Infant wide-field retinal image: 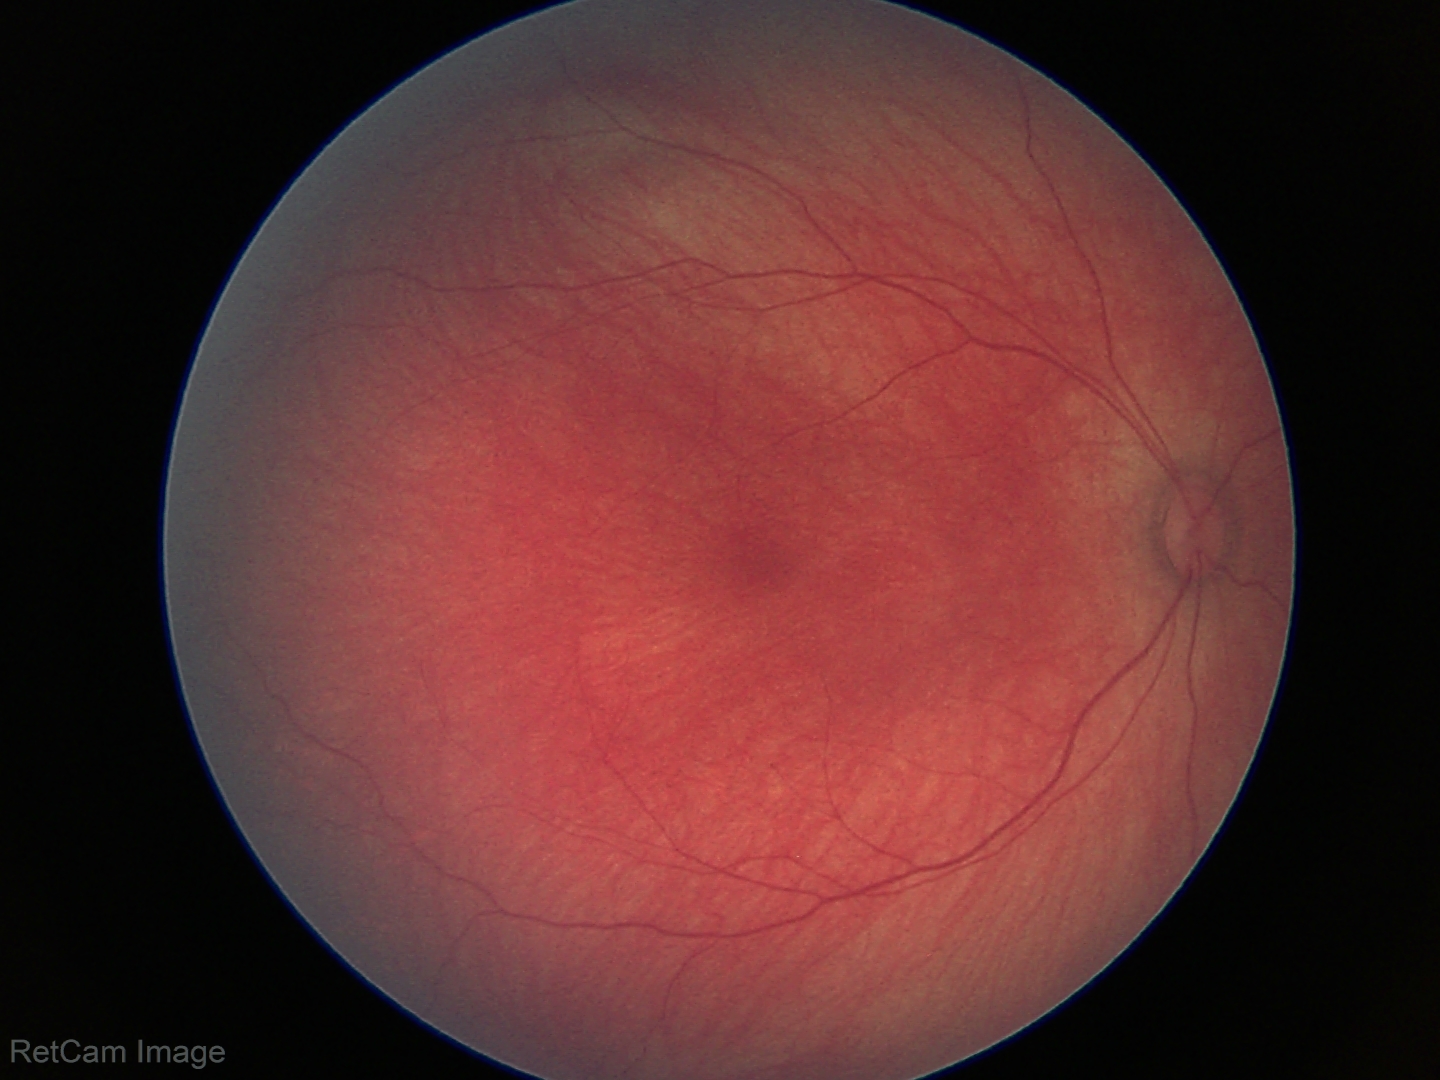

Screening: normal retinal appearance.